45 degree fundus photograph; 848x848; retinal fundus photograph; NIDEK AFC-230 fundus camera:
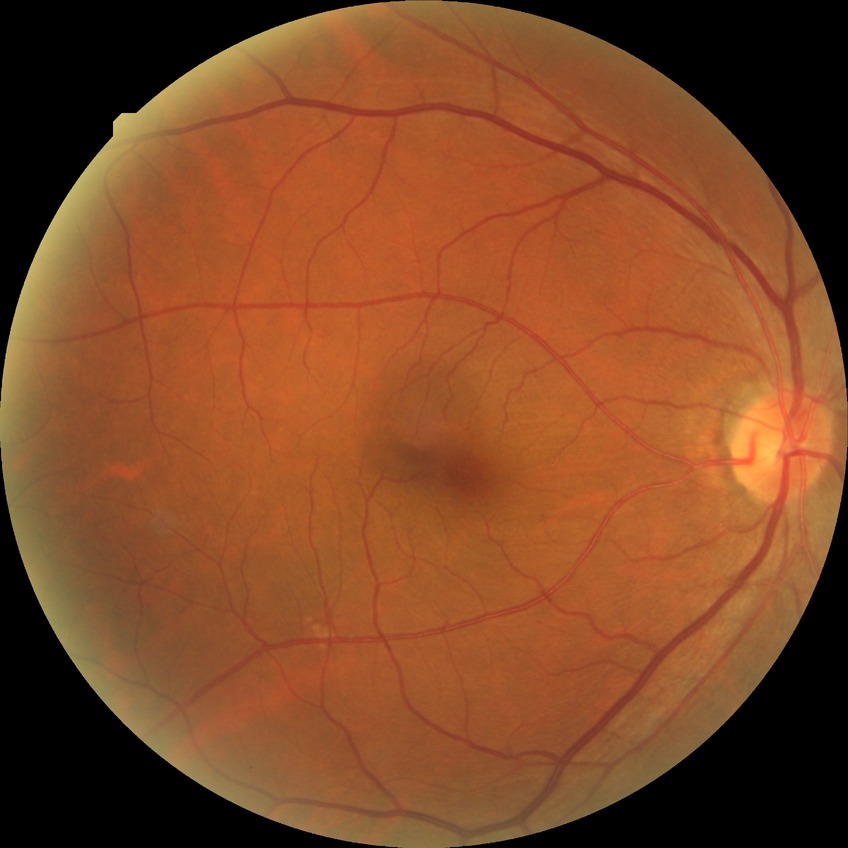

davis_grade: NDR (no diabetic retinopathy)